NIDEK AFC-230 fundus camera. Graded on the modified Davis scale.
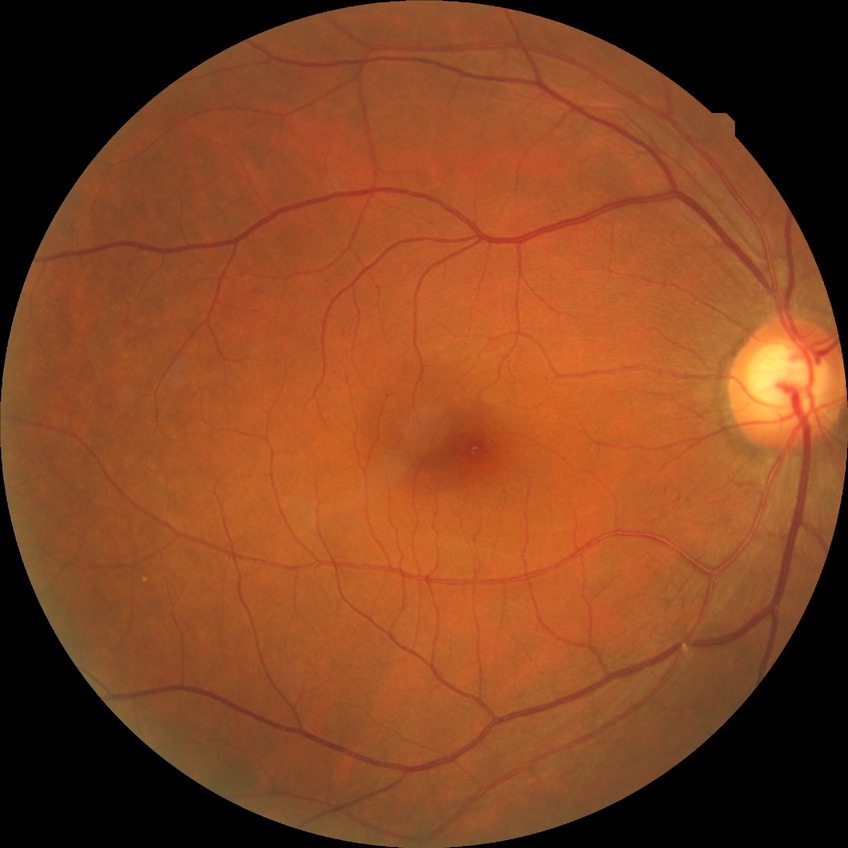

Diabetic retinopathy (DR) is NDR (no diabetic retinopathy).